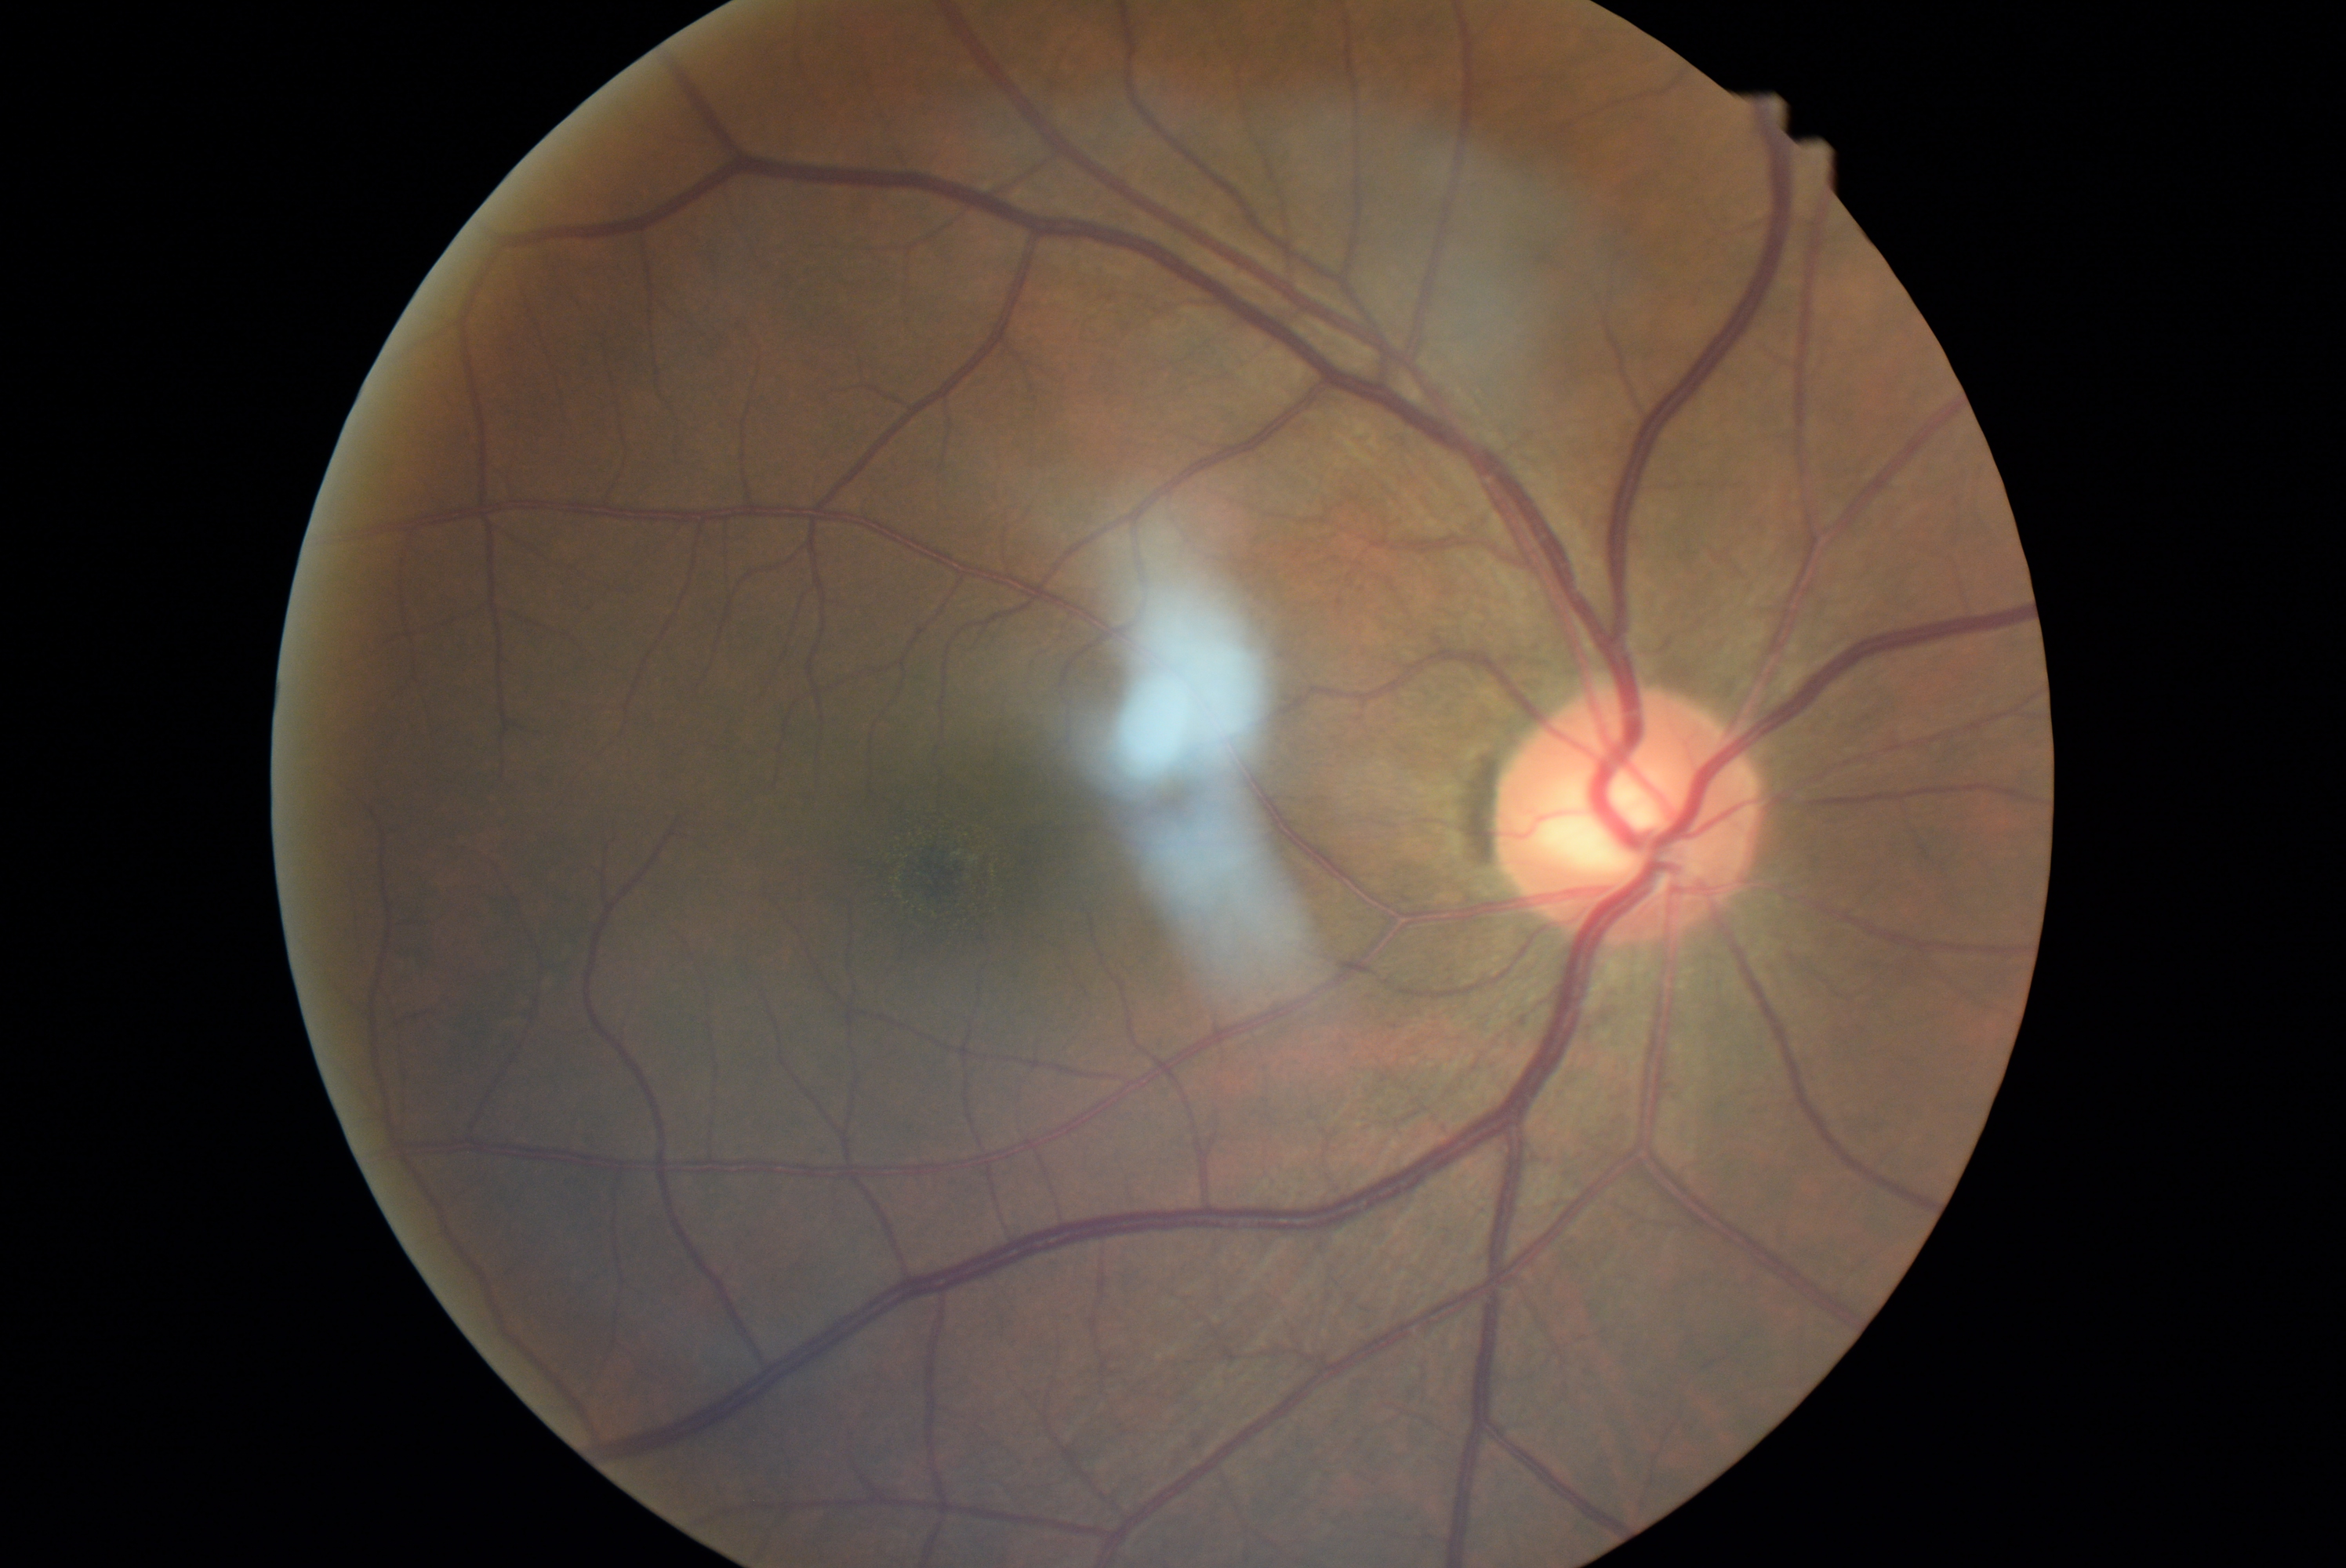 No apparent diabetic retinopathy. DR stage: 0 — no visible signs of diabetic retinopathy.